NIDEK AFC-230
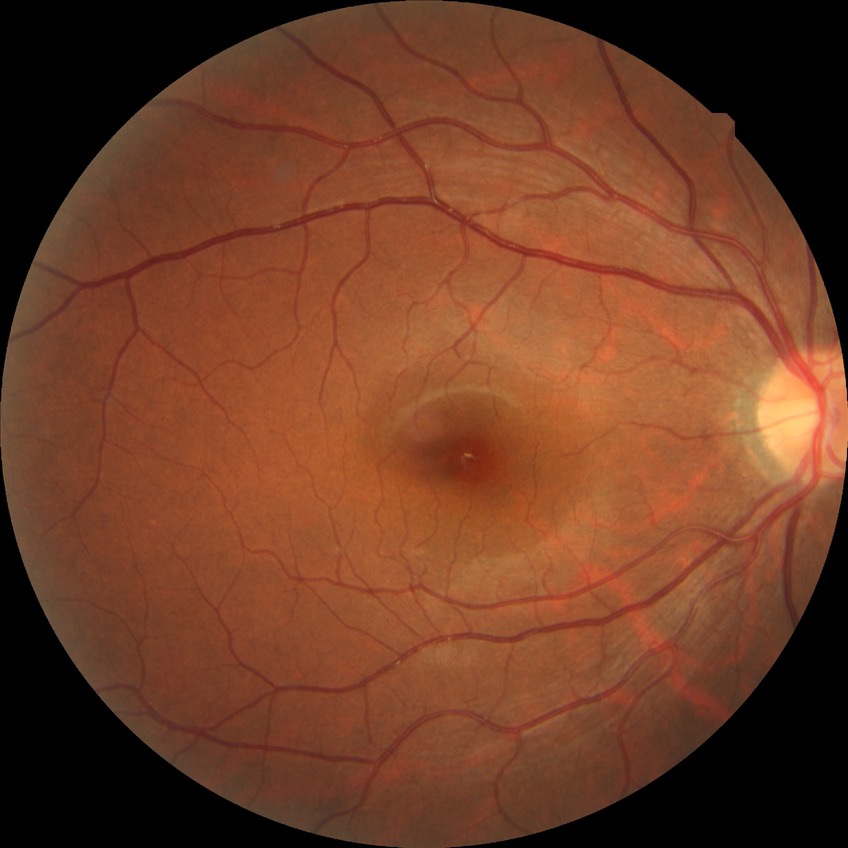

diabetic retinopathy (DR): no diabetic retinopathy (NDR).